Wide-field fundus photograph from neonatal ROP screening — 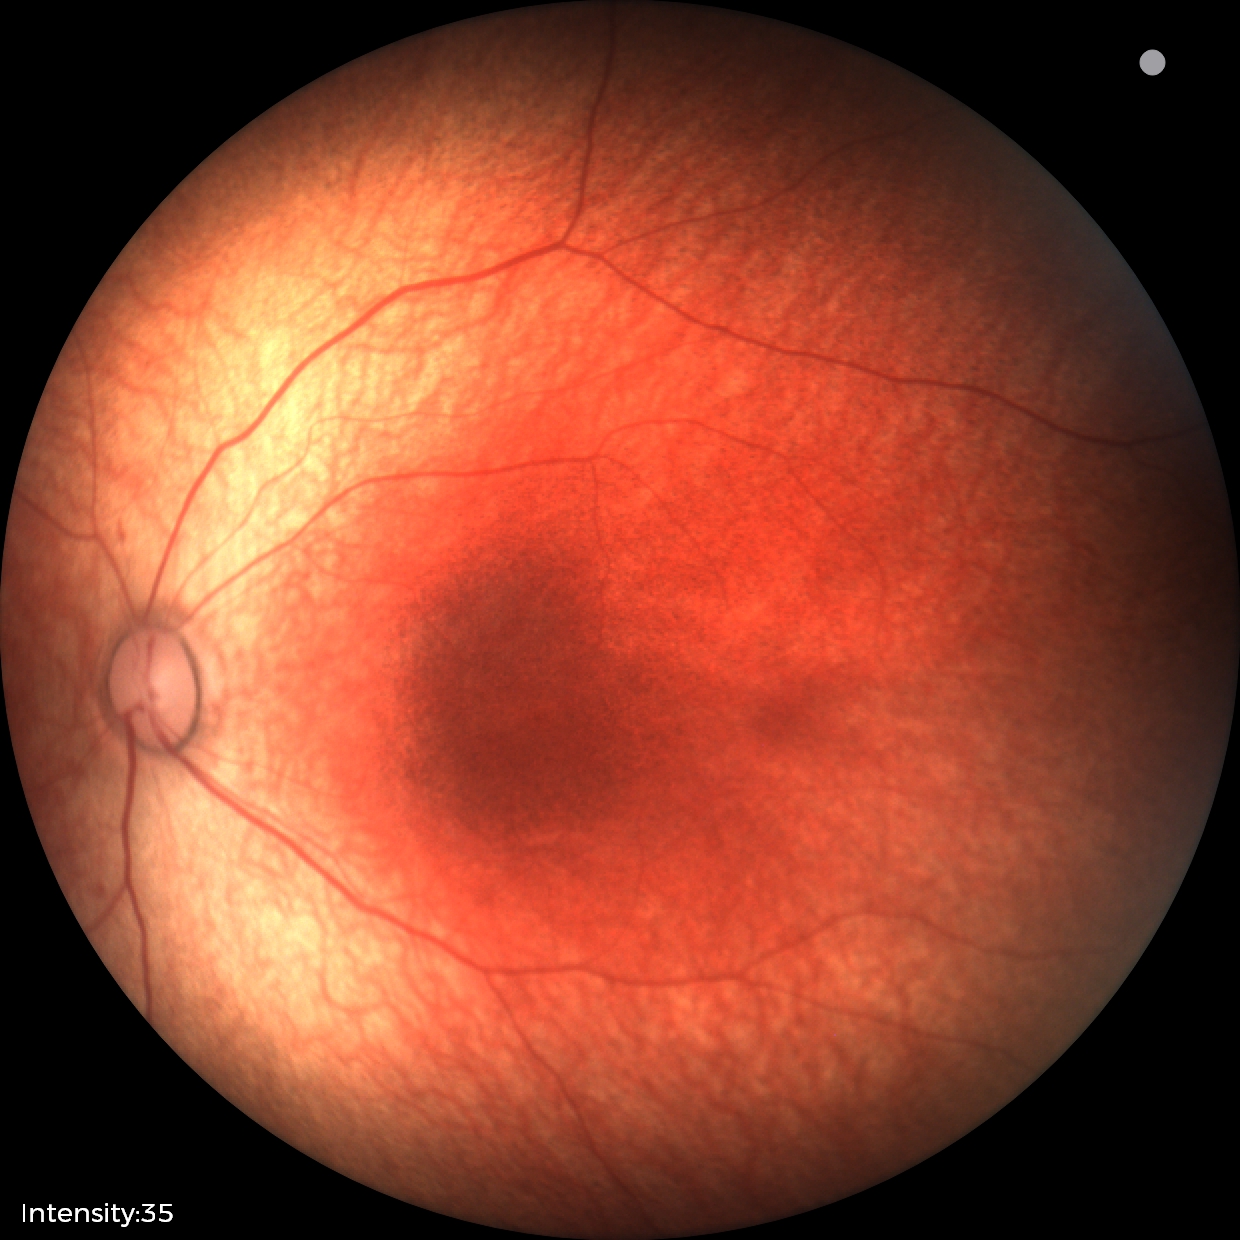 Screening diagnosis: physiological appearance with no retinal pathology.